2212x1659 · fundus photo:
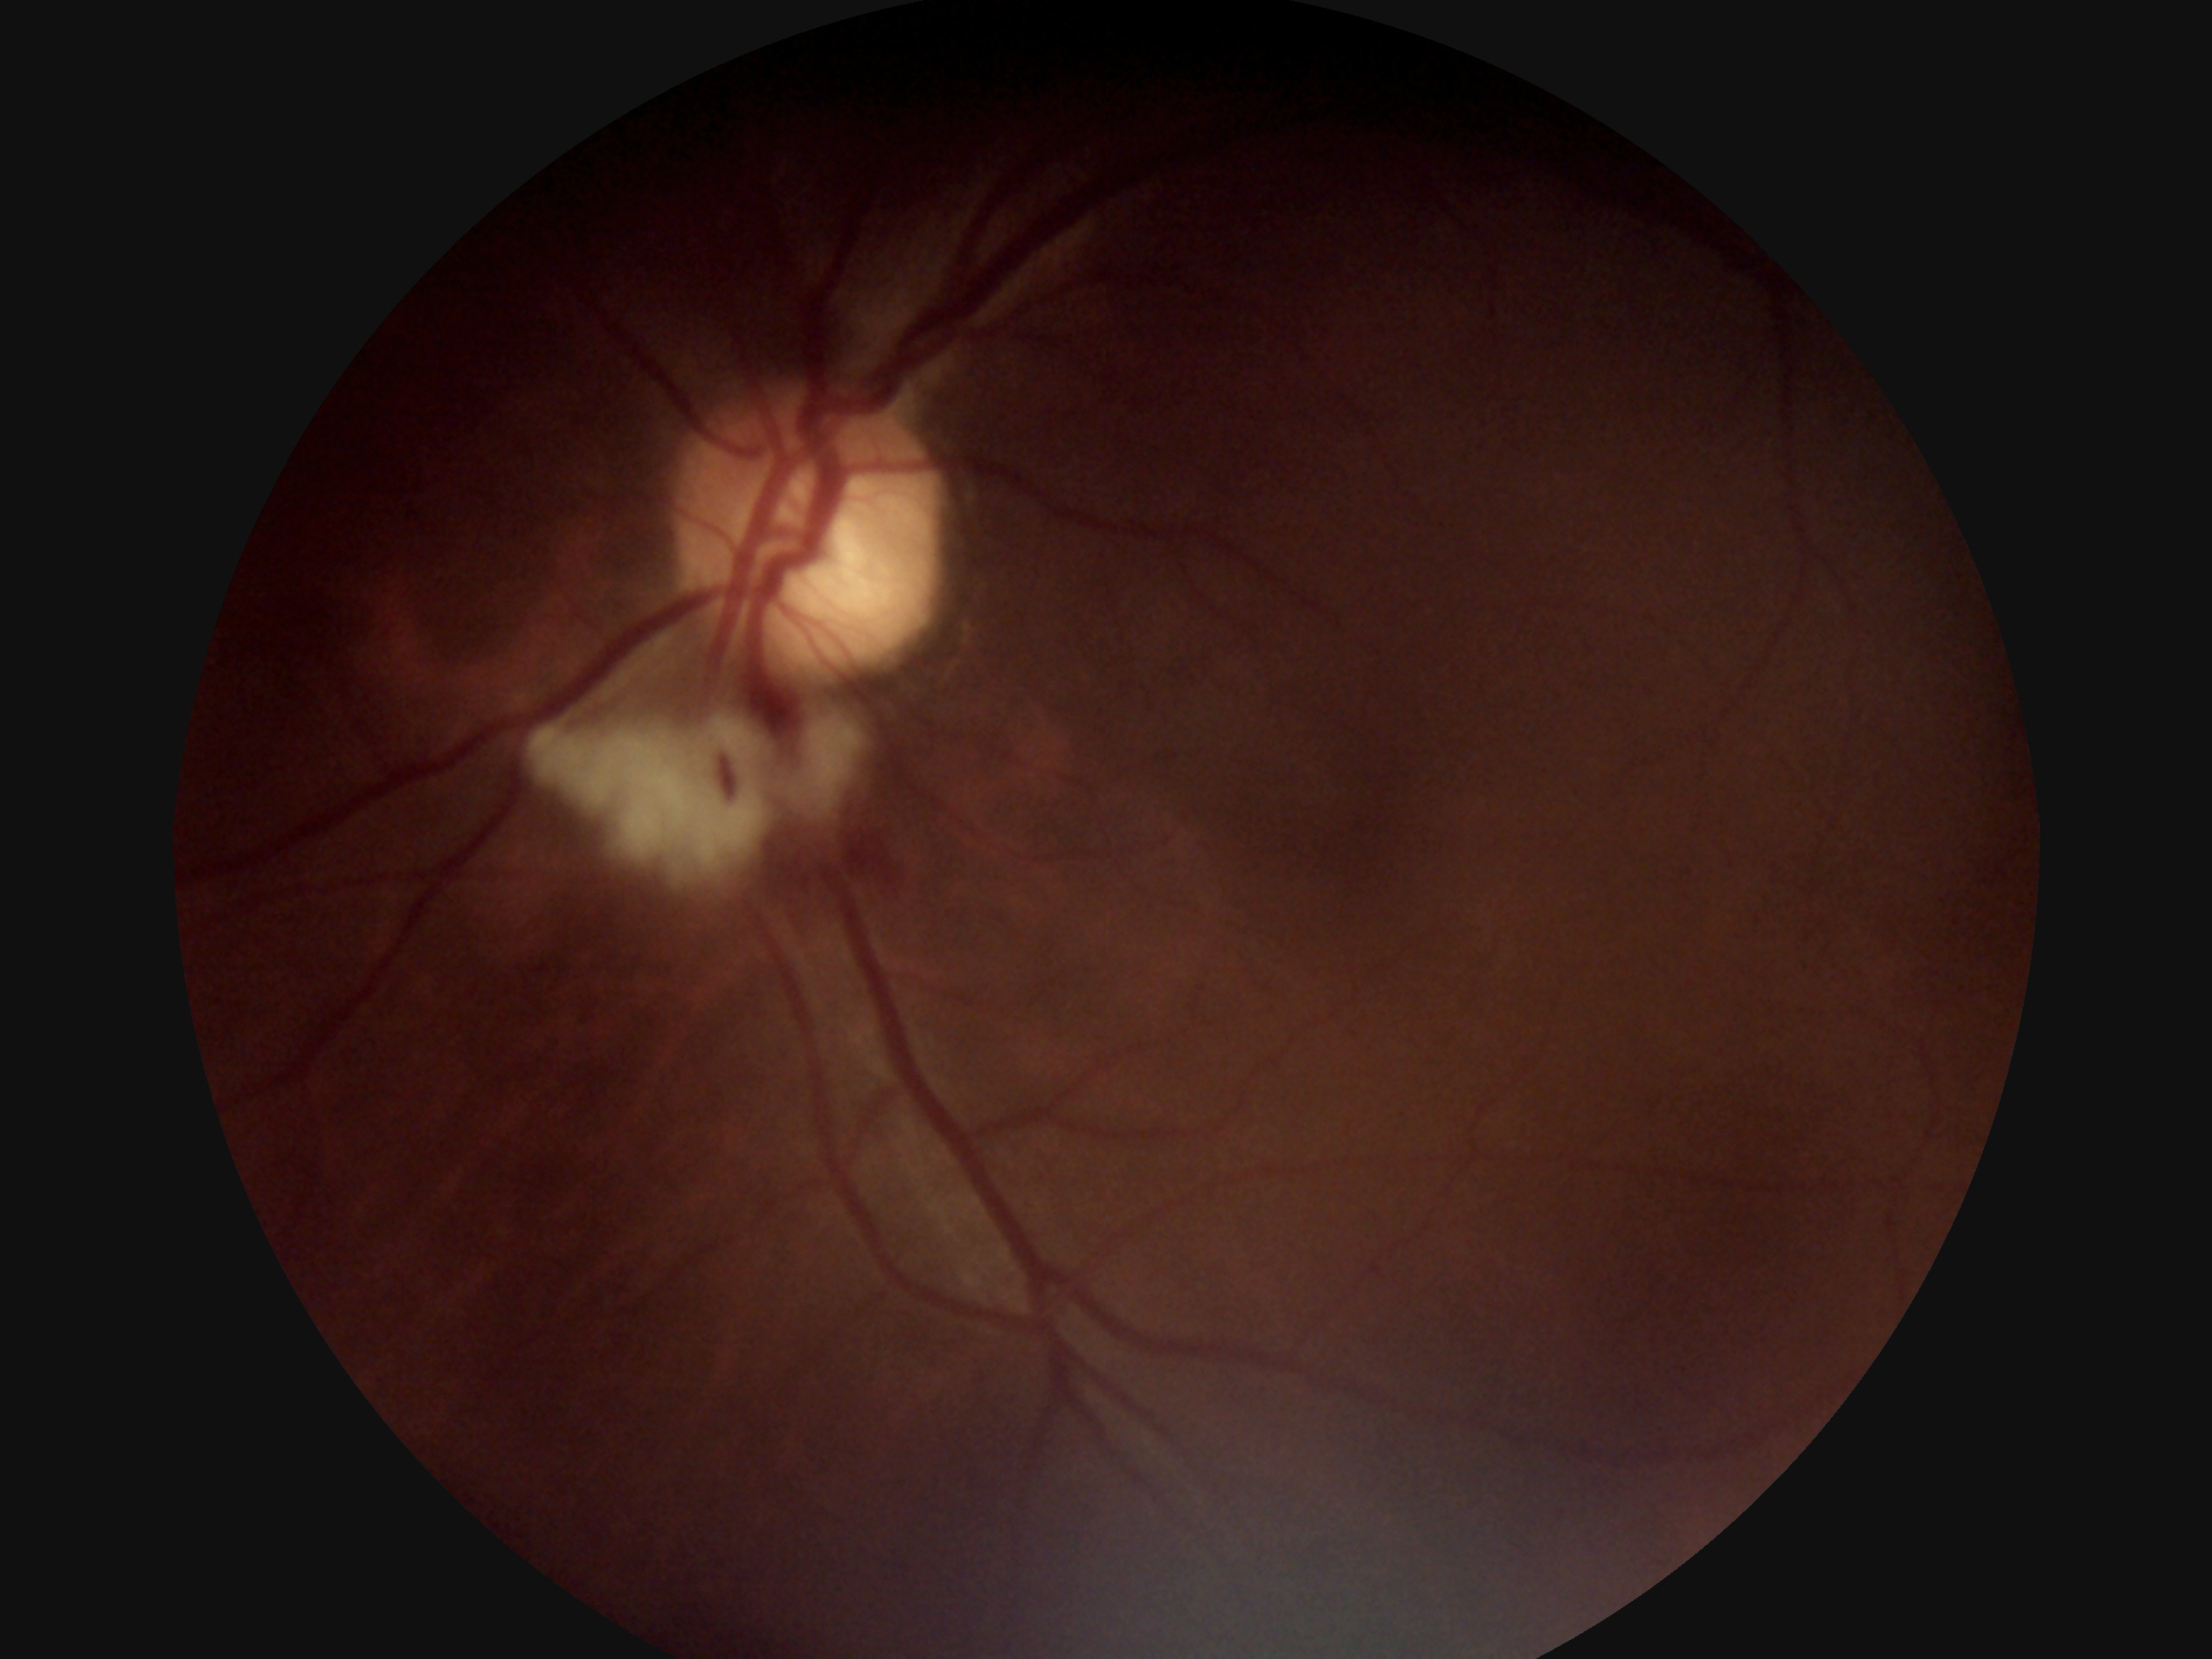

DR grade: 2/4.